Camera: Phoenix ICON (100° FOV); 1240x1240px; wide-field fundus image from infant ROP screening — 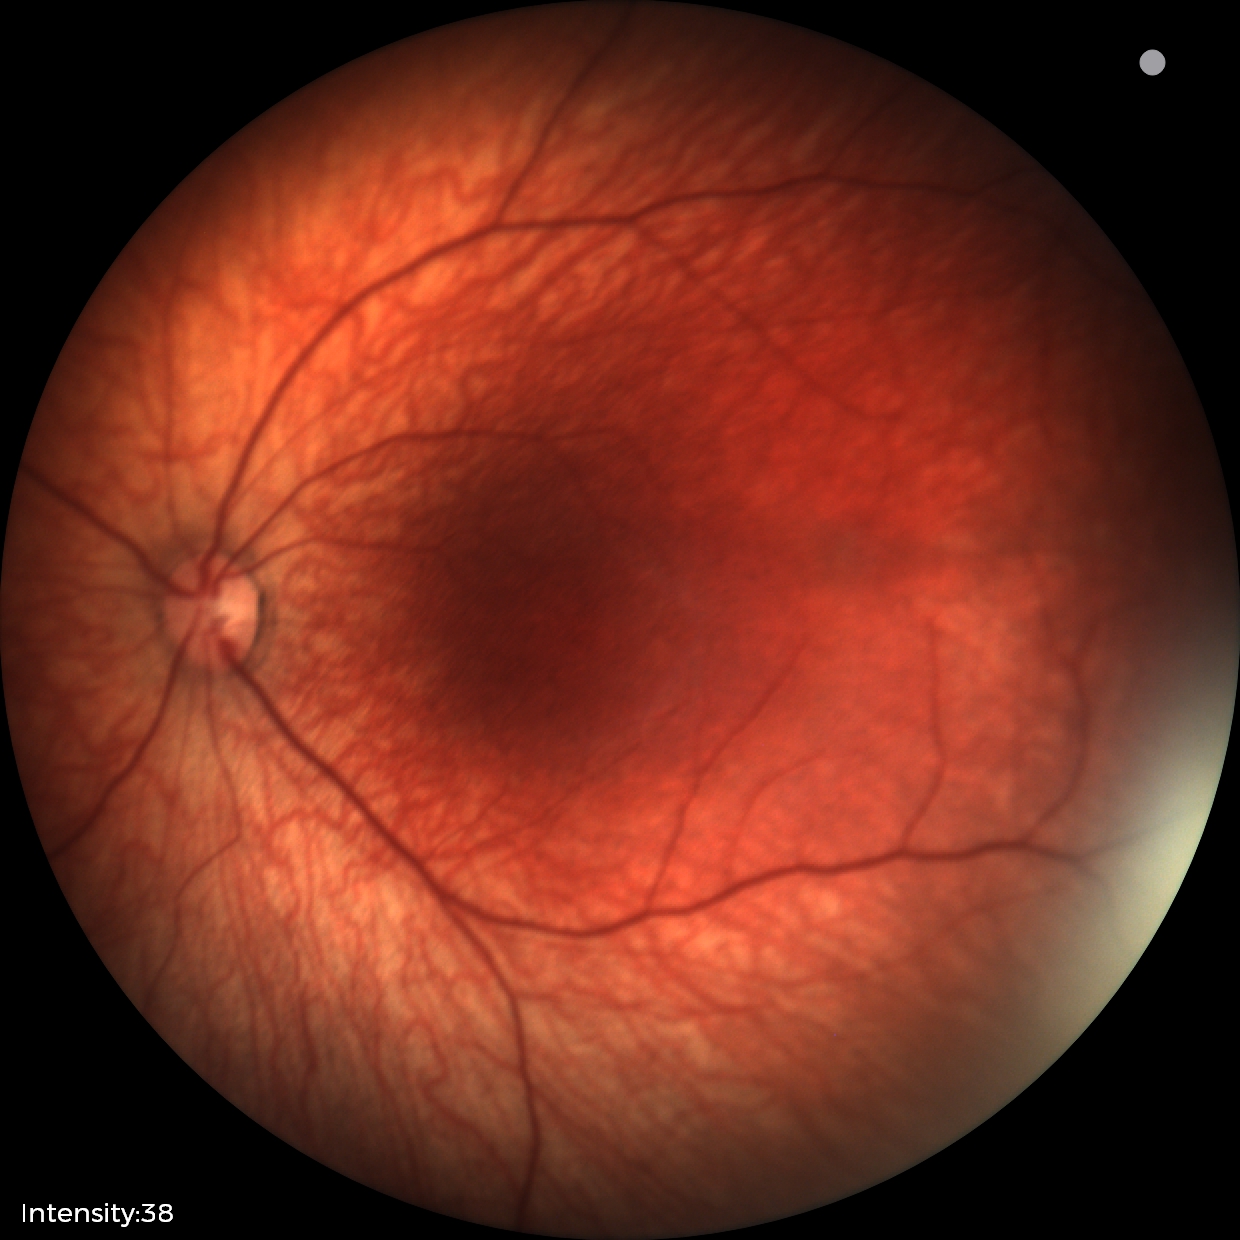
No retinal pathology identified on screening.